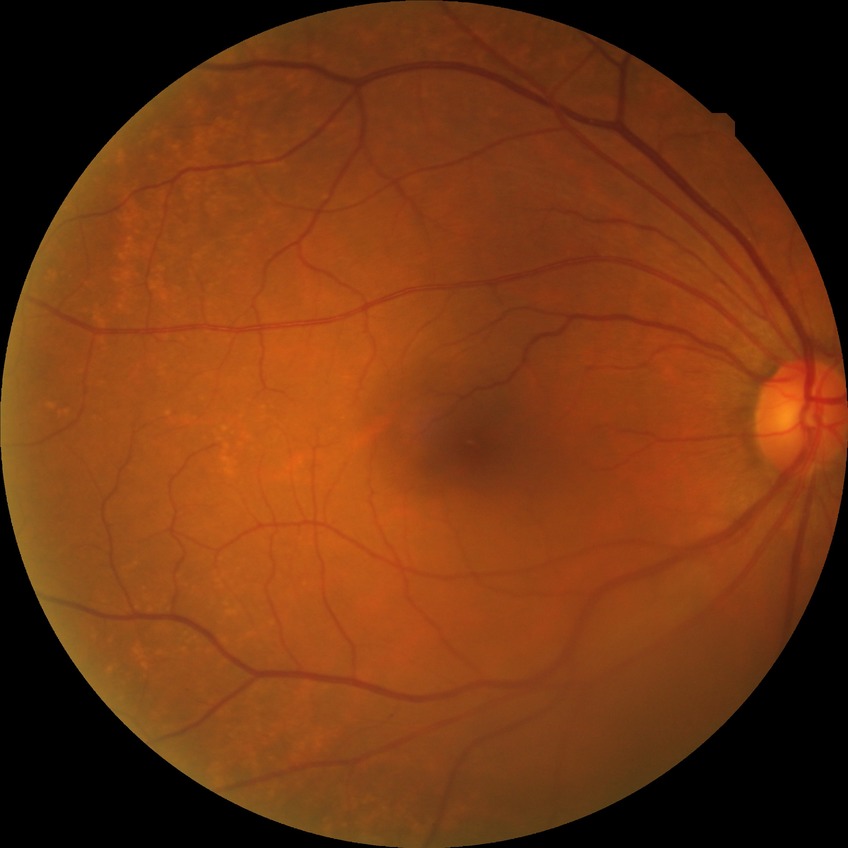

Diabetic retinopathy (DR): no diabetic retinopathy (NDR).